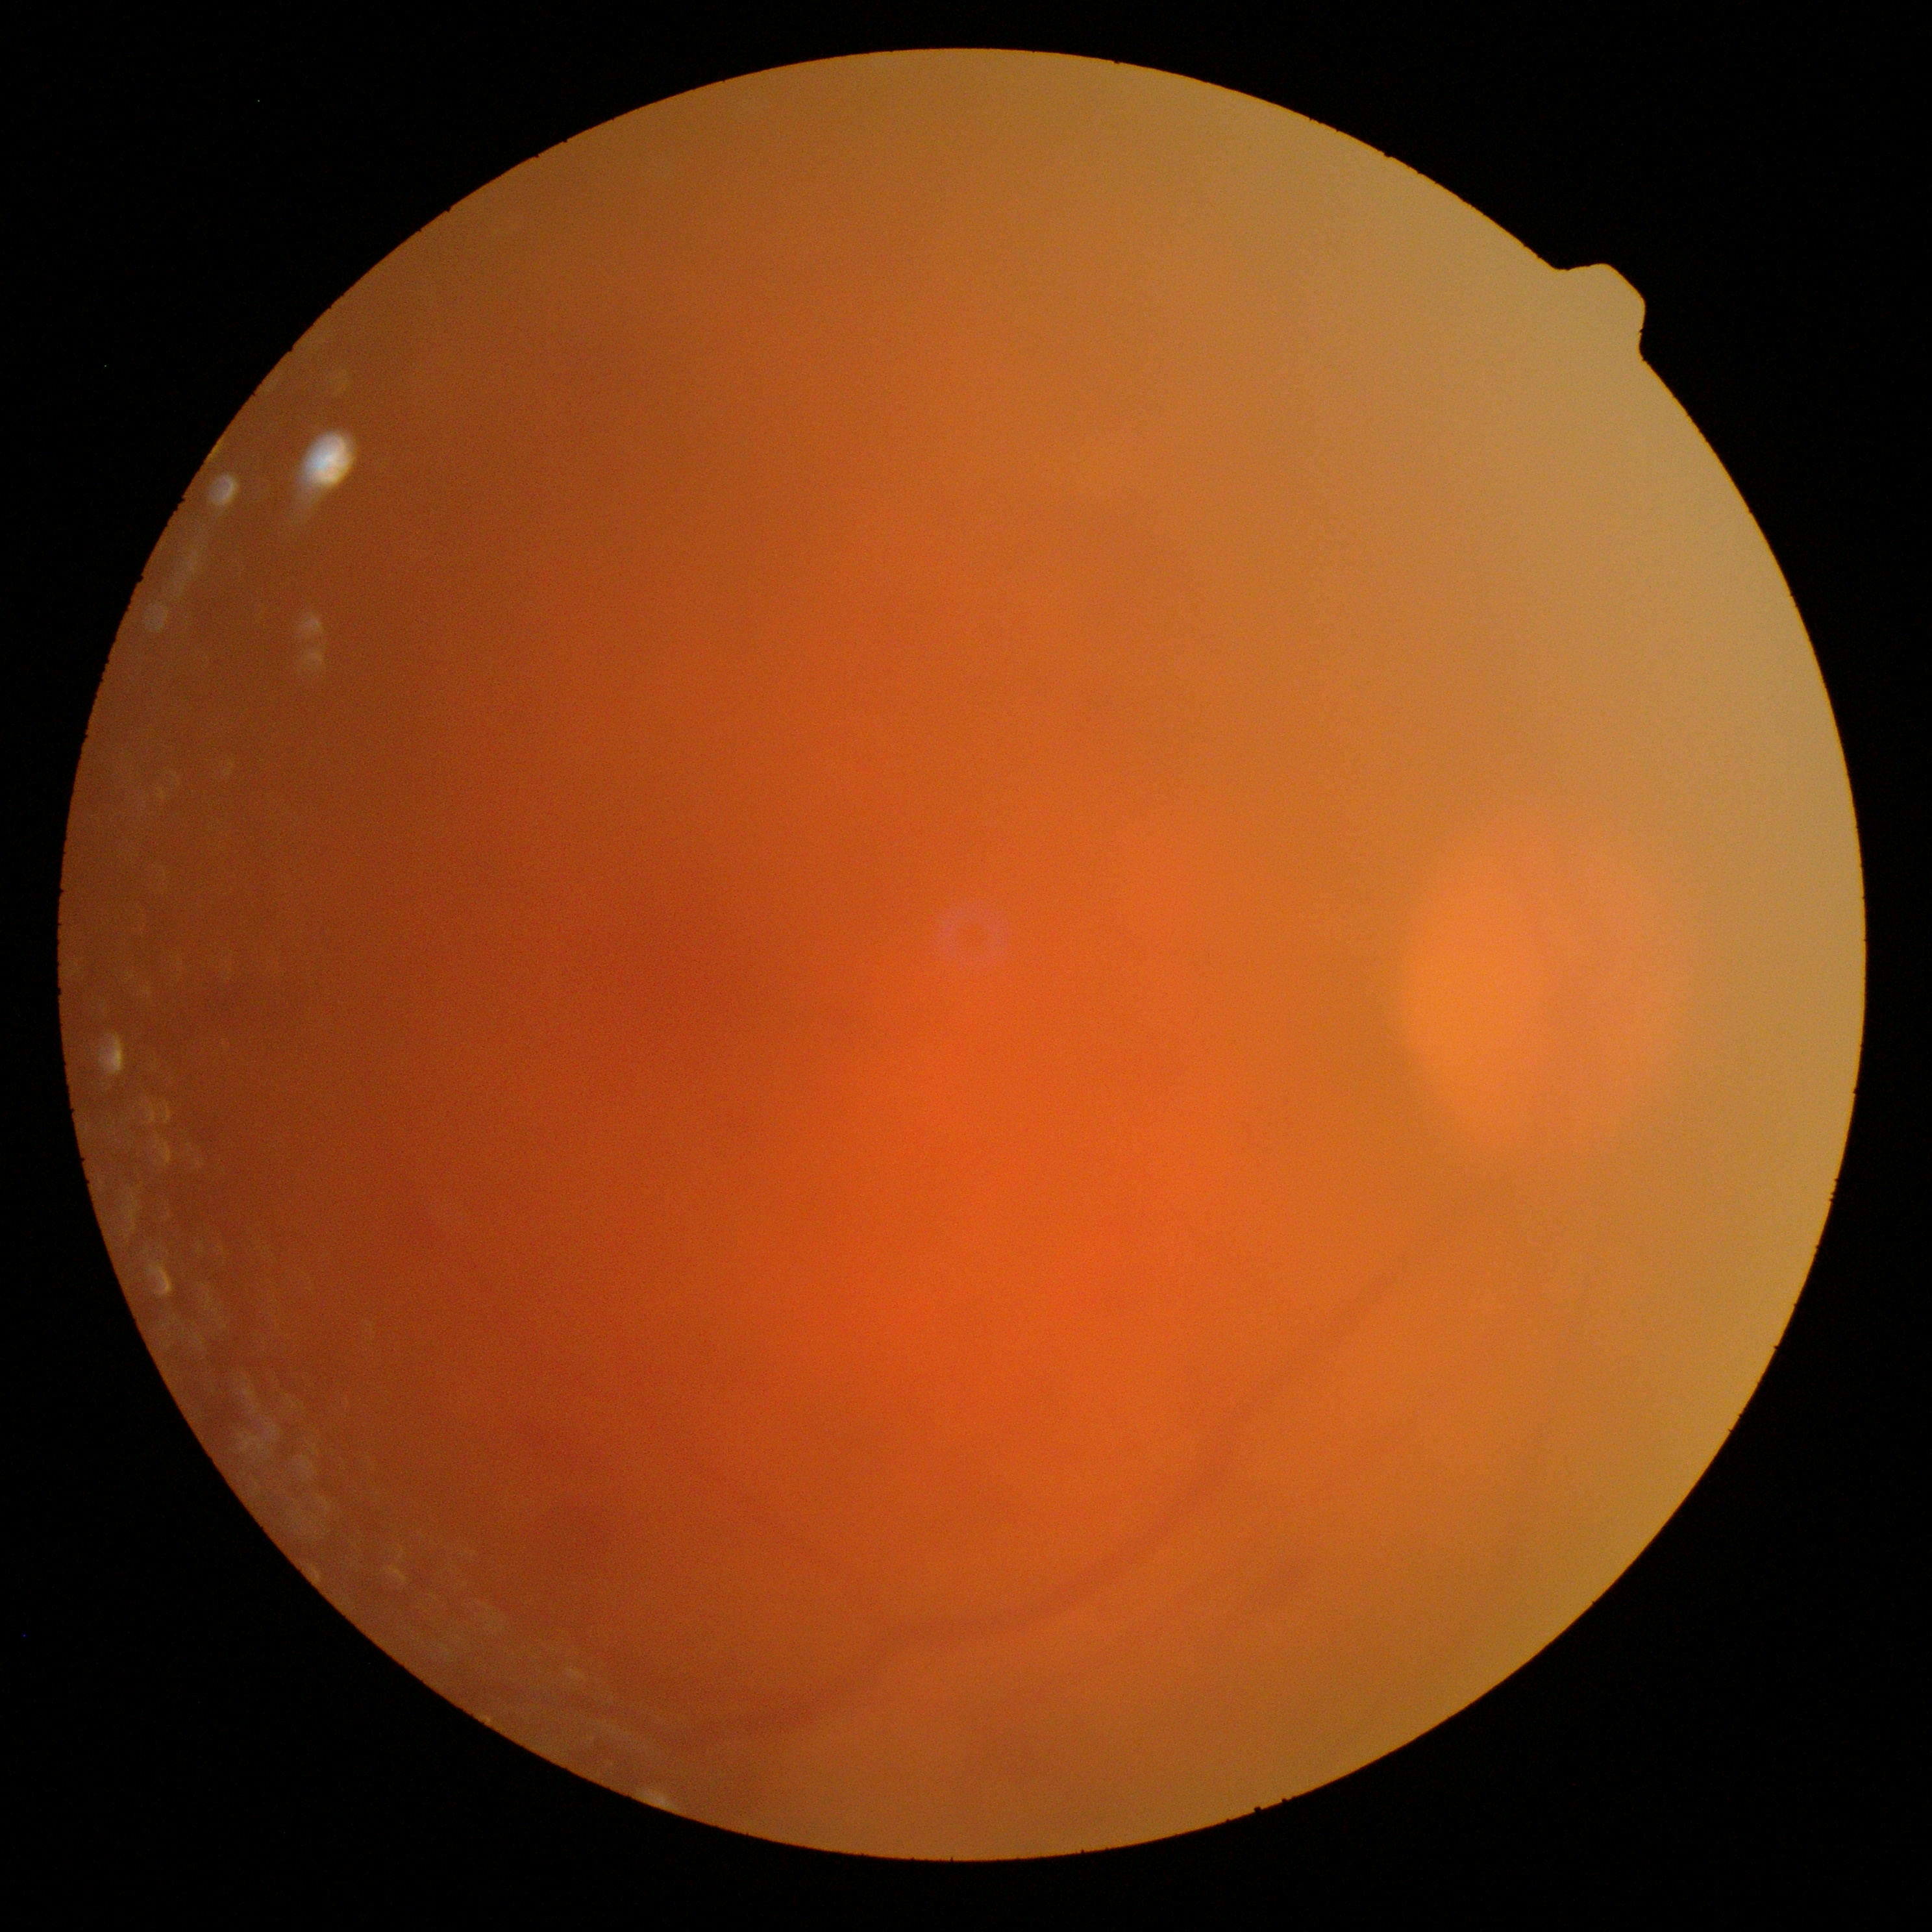

Diabetic retinopathy grade is ungradable due to poor image quality.